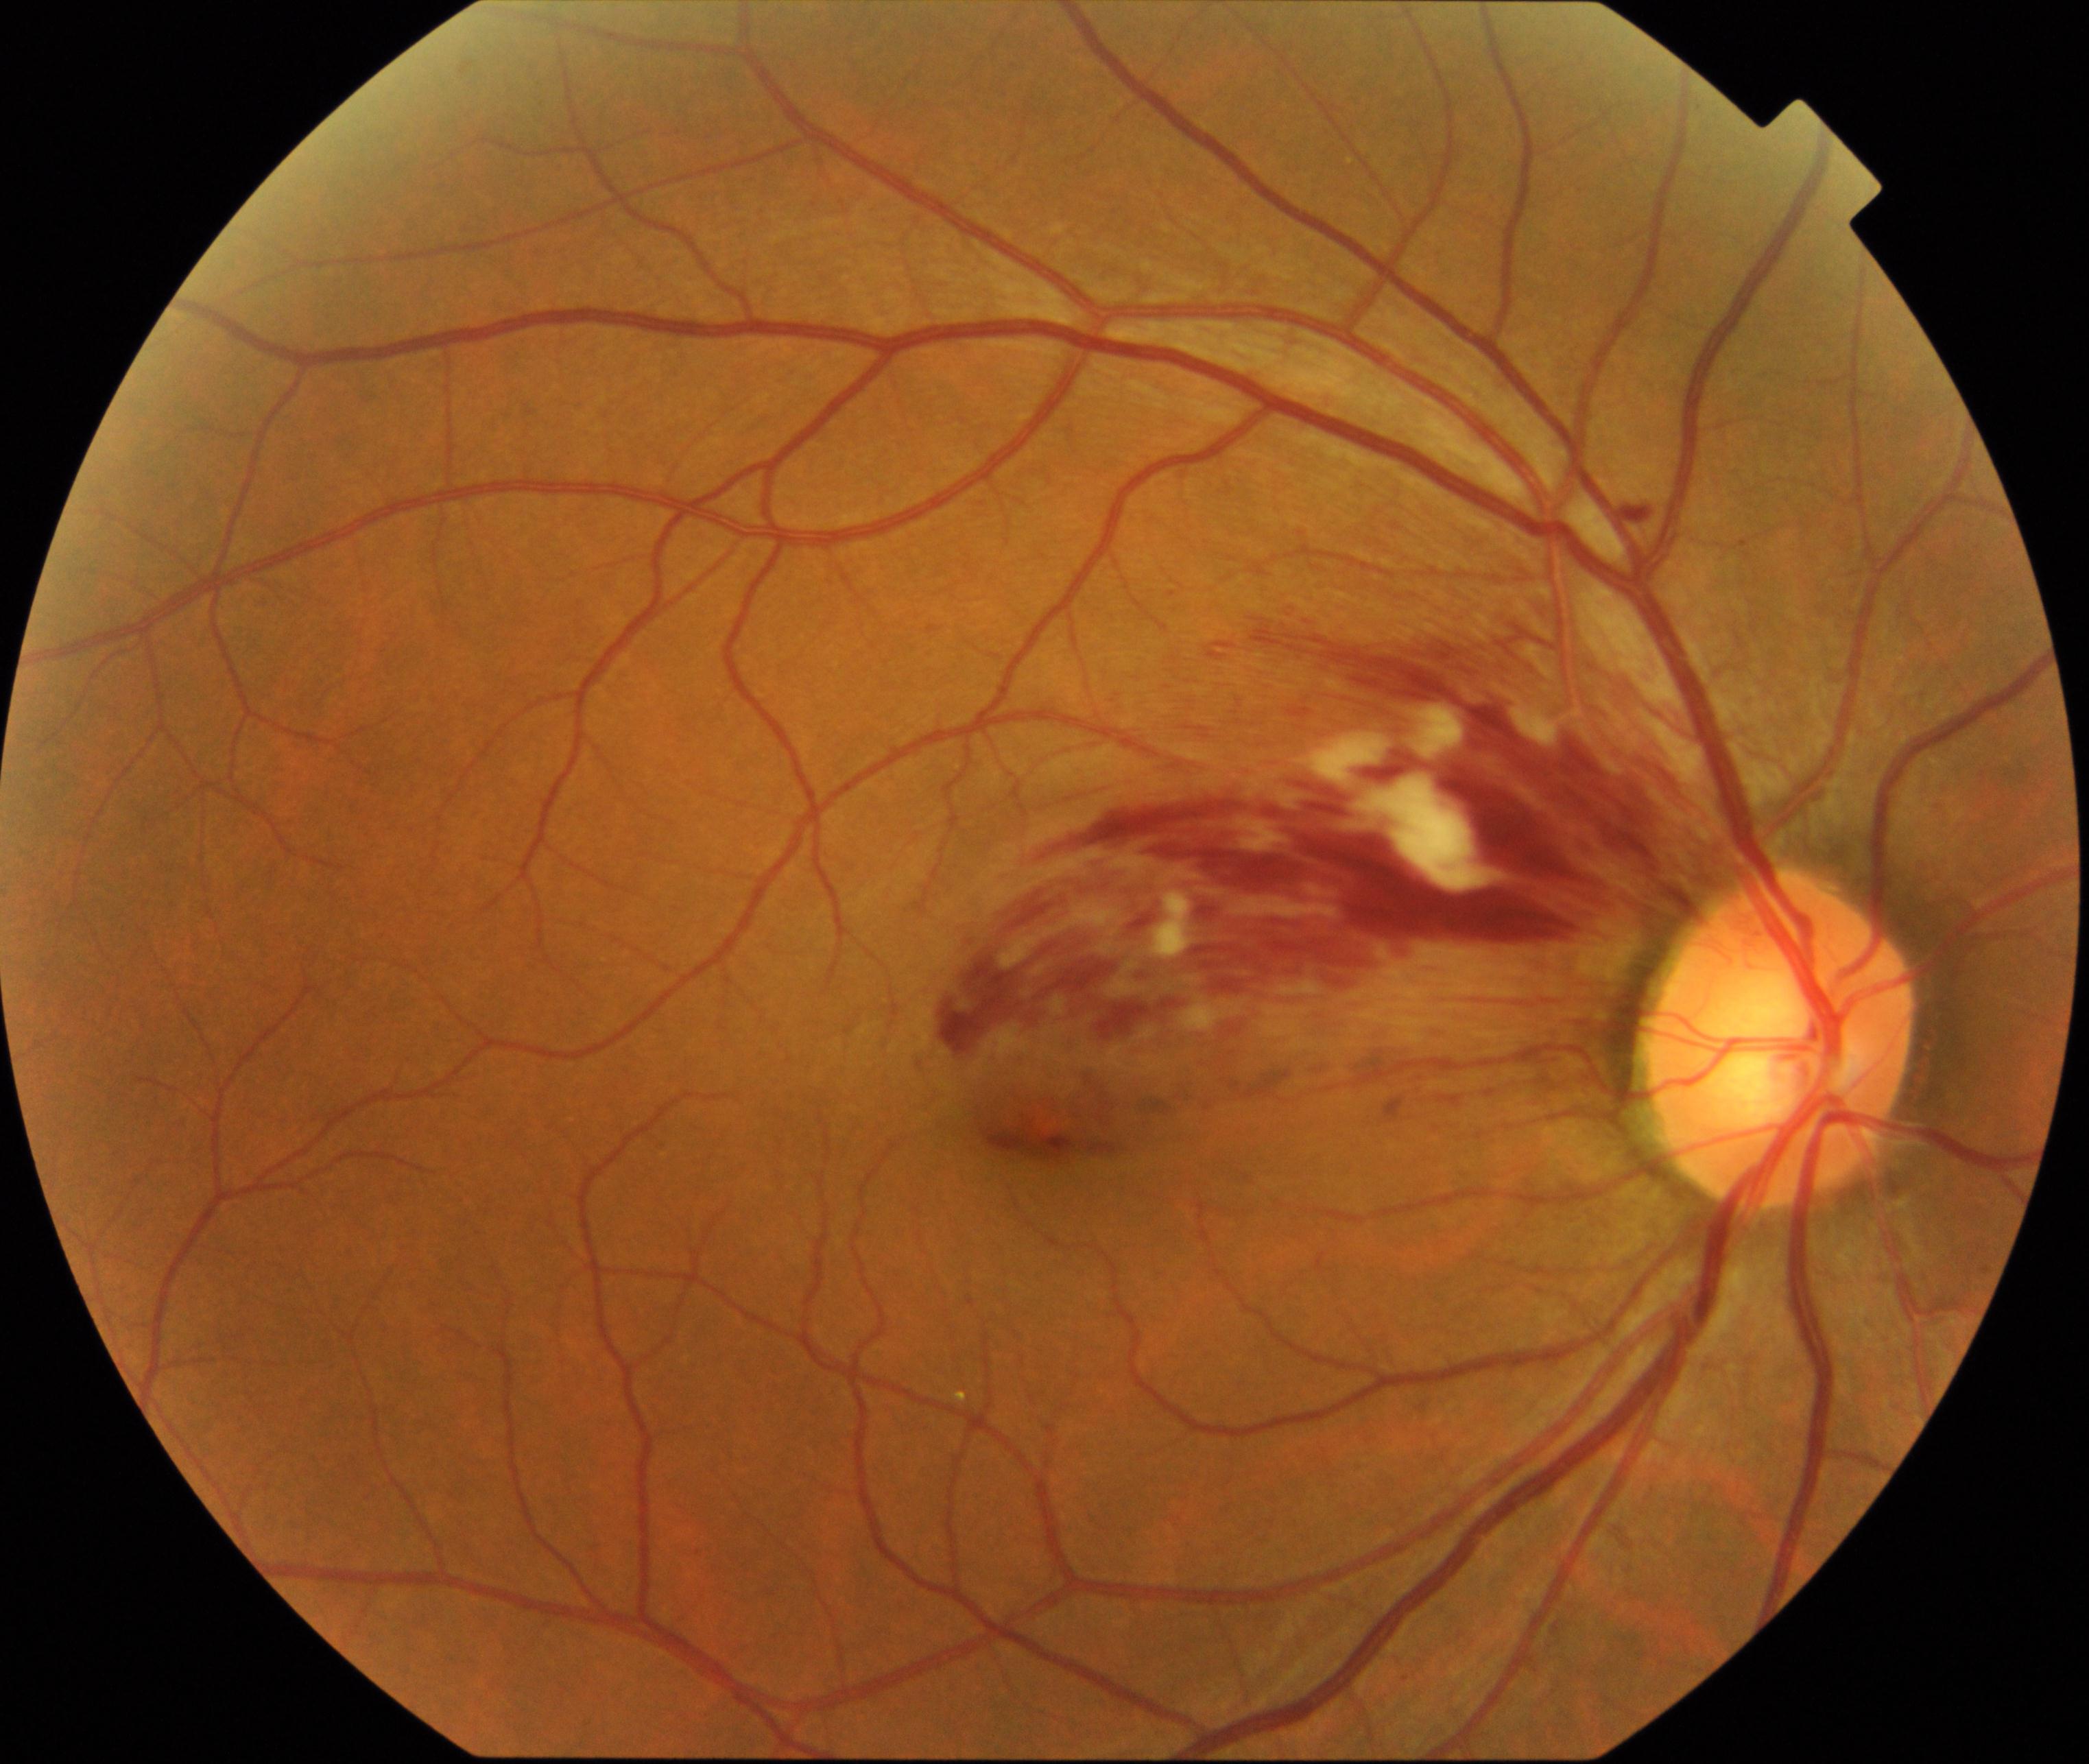 Classification: branch retinal vein occlusion (BRVO).